640x480; Clarity RetCam 3, 130° FOV; pediatric retinal photograph (wide-field).
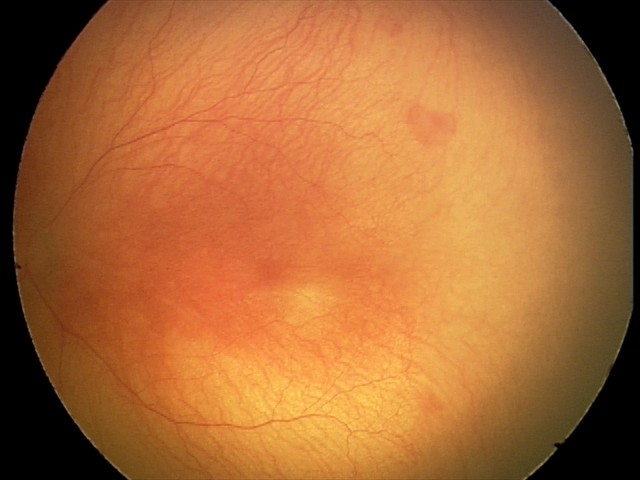

Examination diagnosed as aggressive ROP (A-ROP). Plus disease present.